Diabetic retinopathy graded by the modified Davis classification
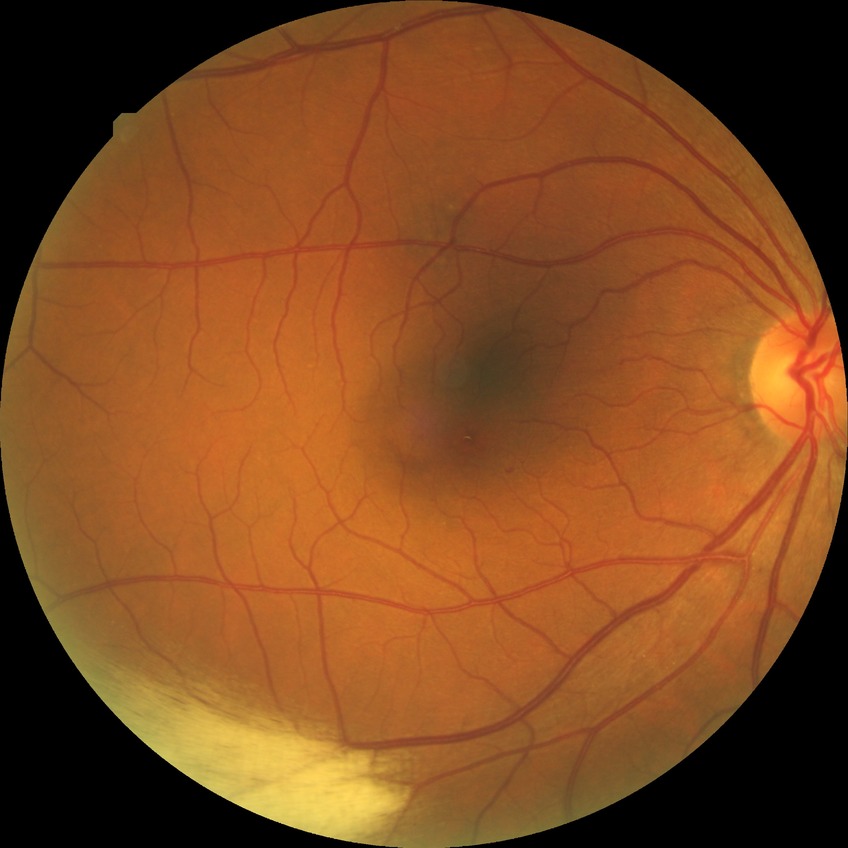
Diabetic retinopathy (DR): SDR (simple diabetic retinopathy).